Ultra-widefield (UWF) fundus image:
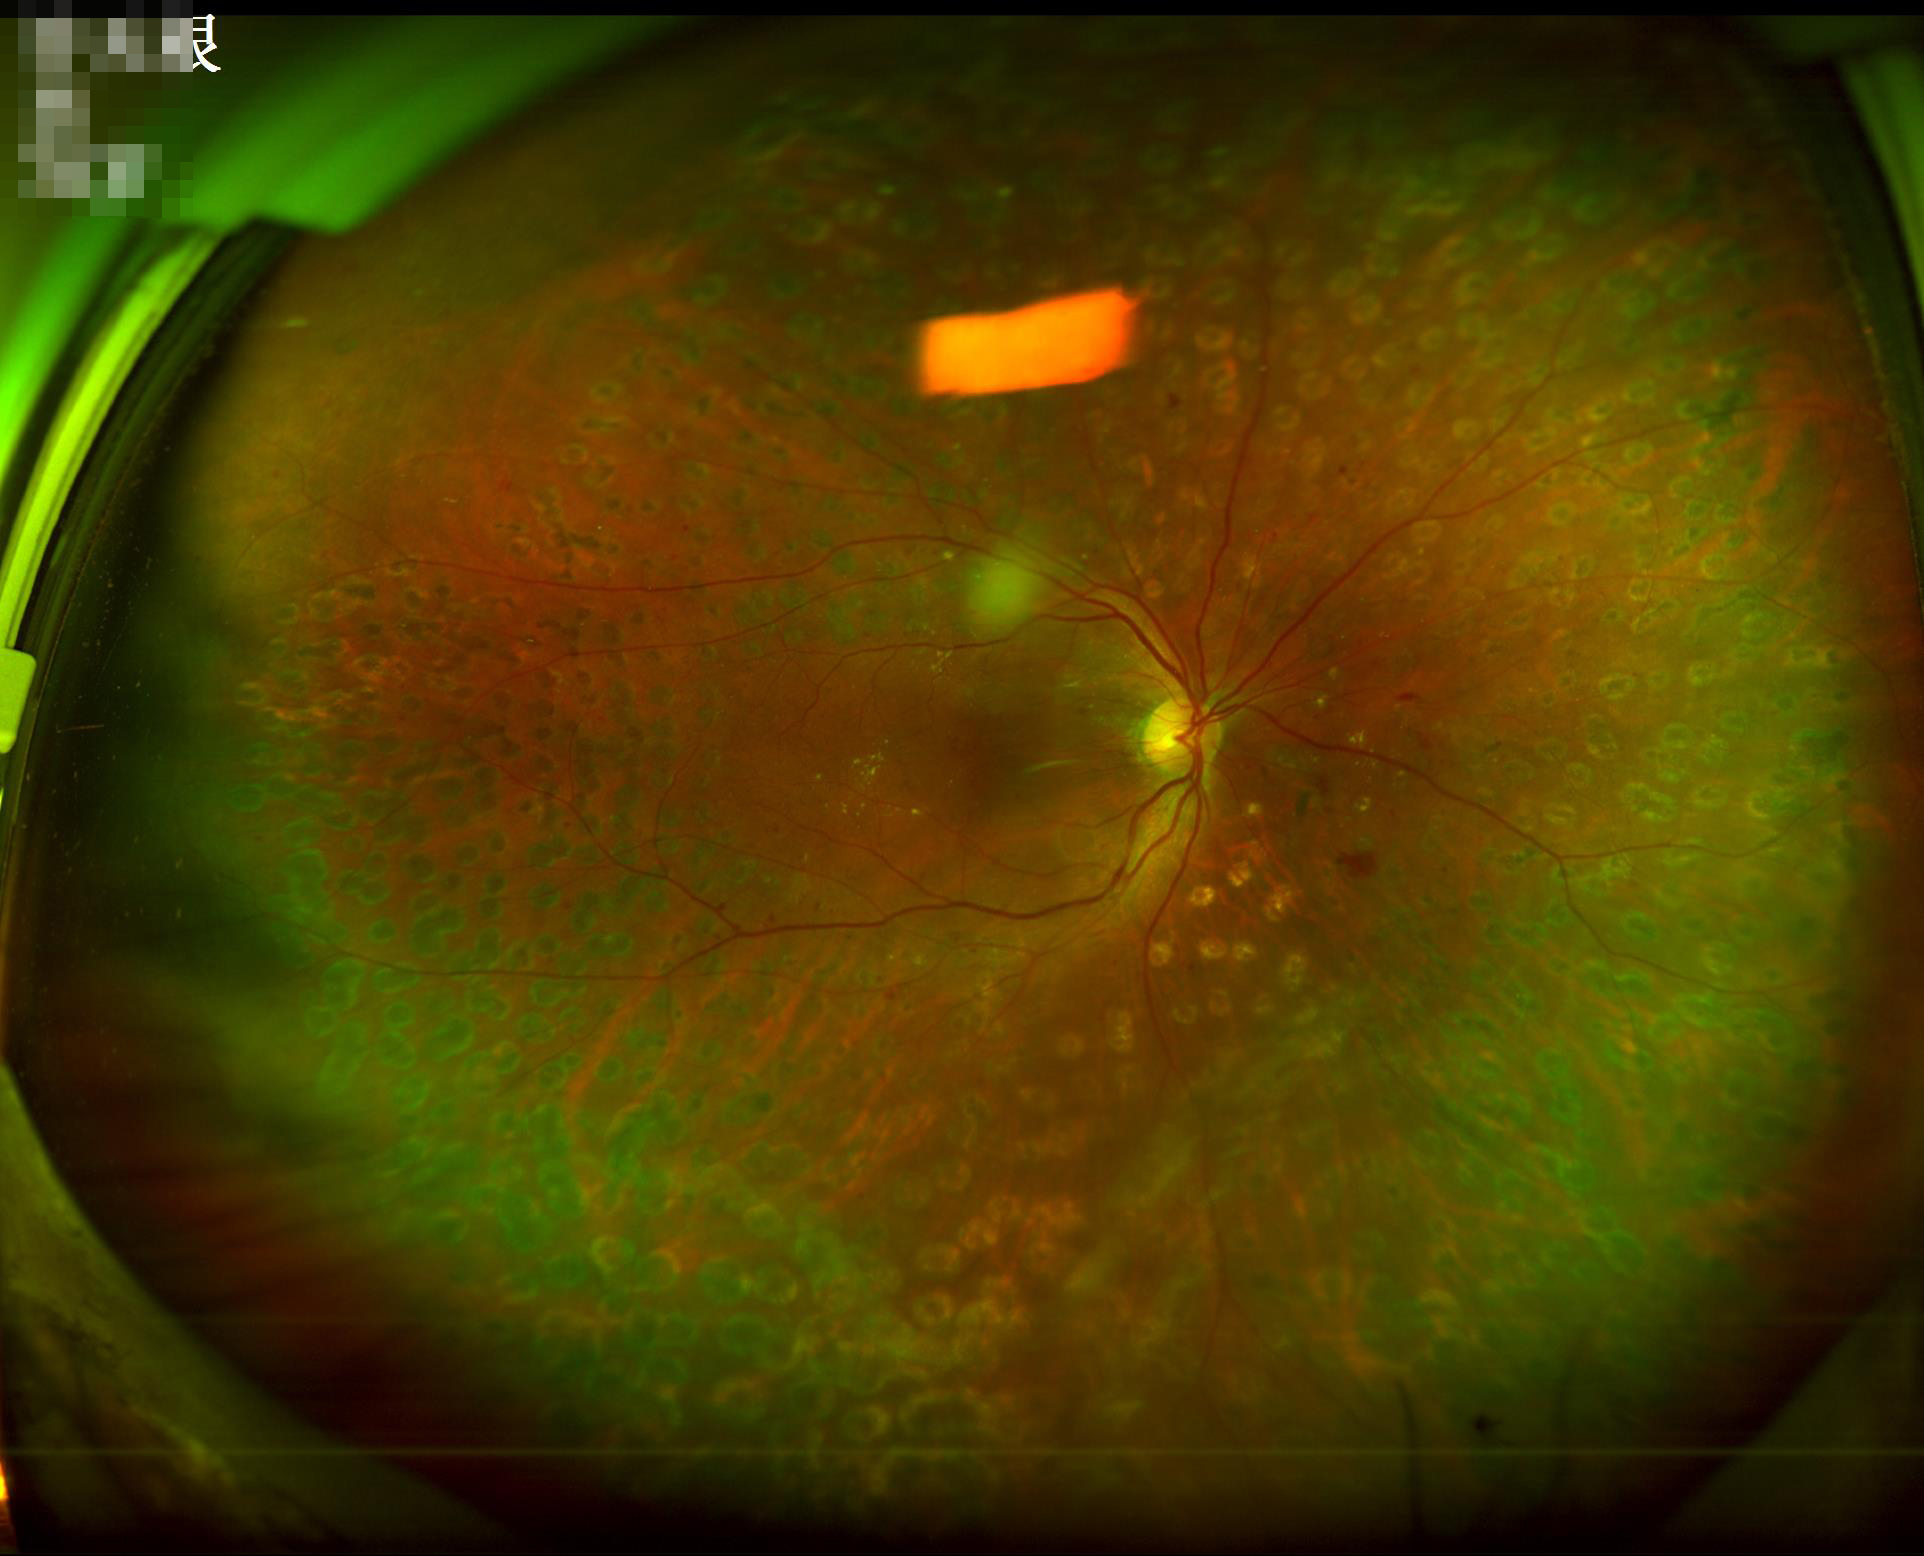 Illumination is uneven. The image is clear. Acceptable image quality. Vessels and details are readily distinguishable.